45-degree field of view: 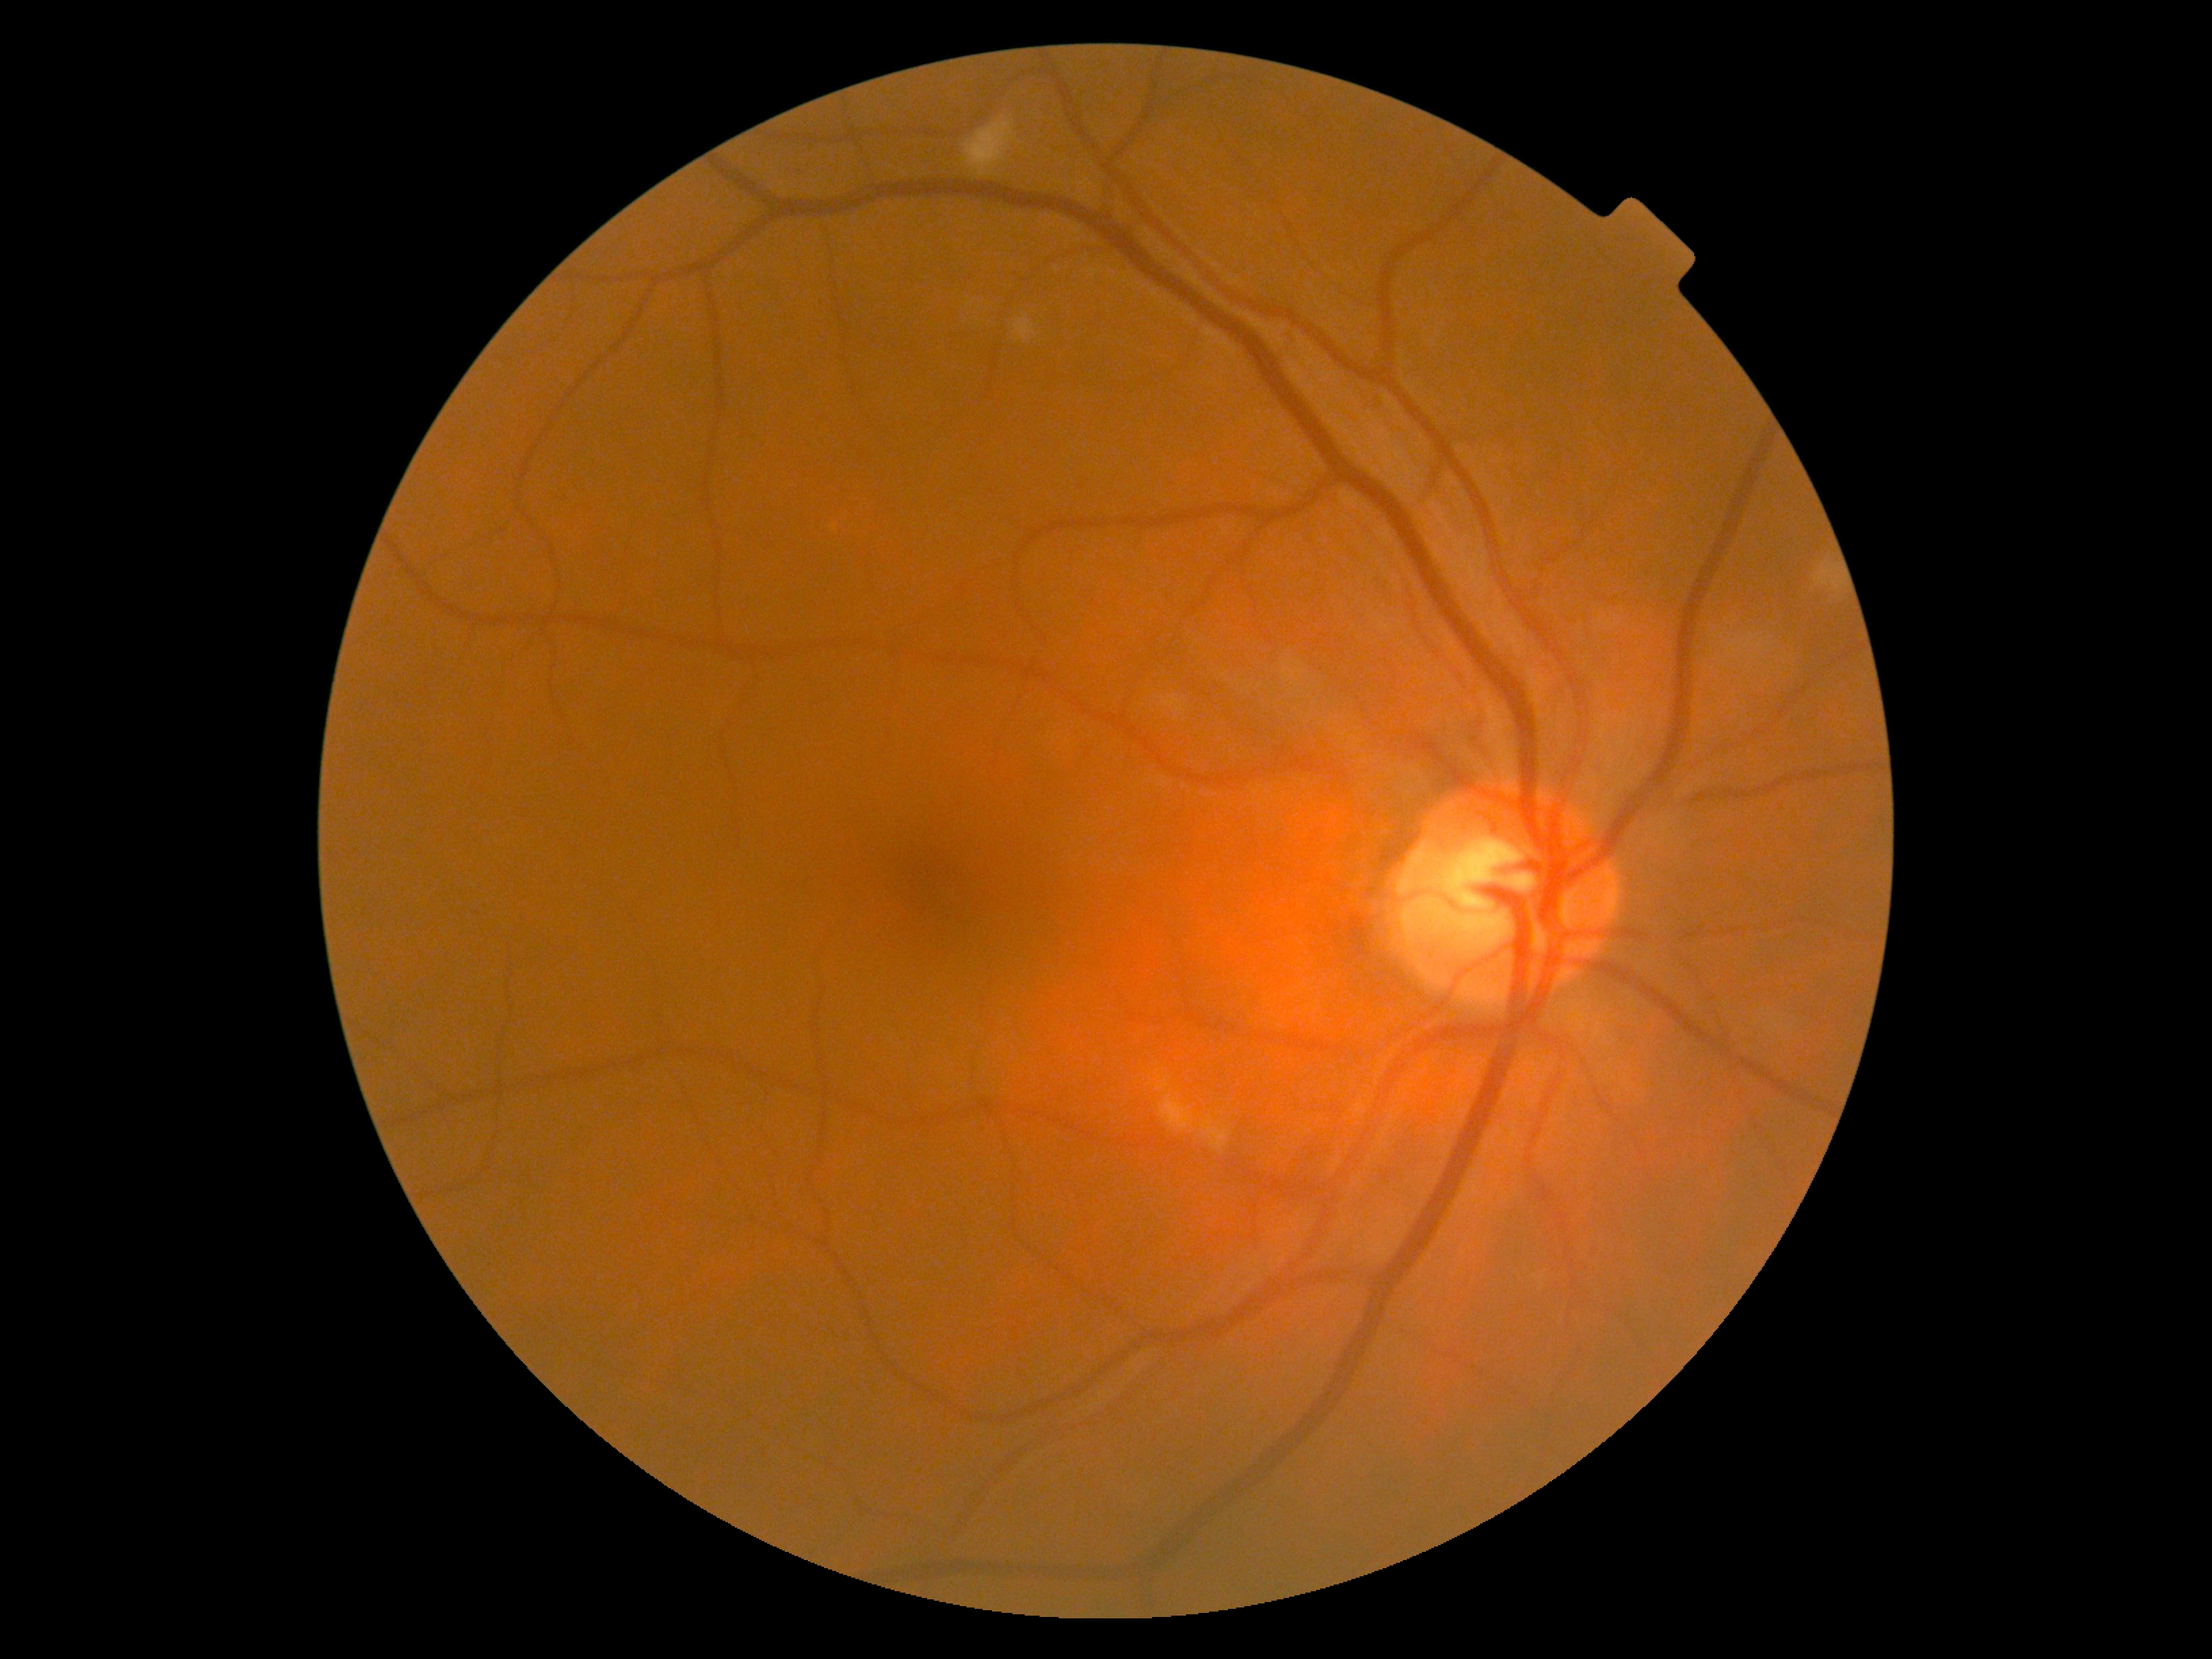 DR class = non-proliferative diabetic retinopathy, diabetic retinopathy (DR) = 2.